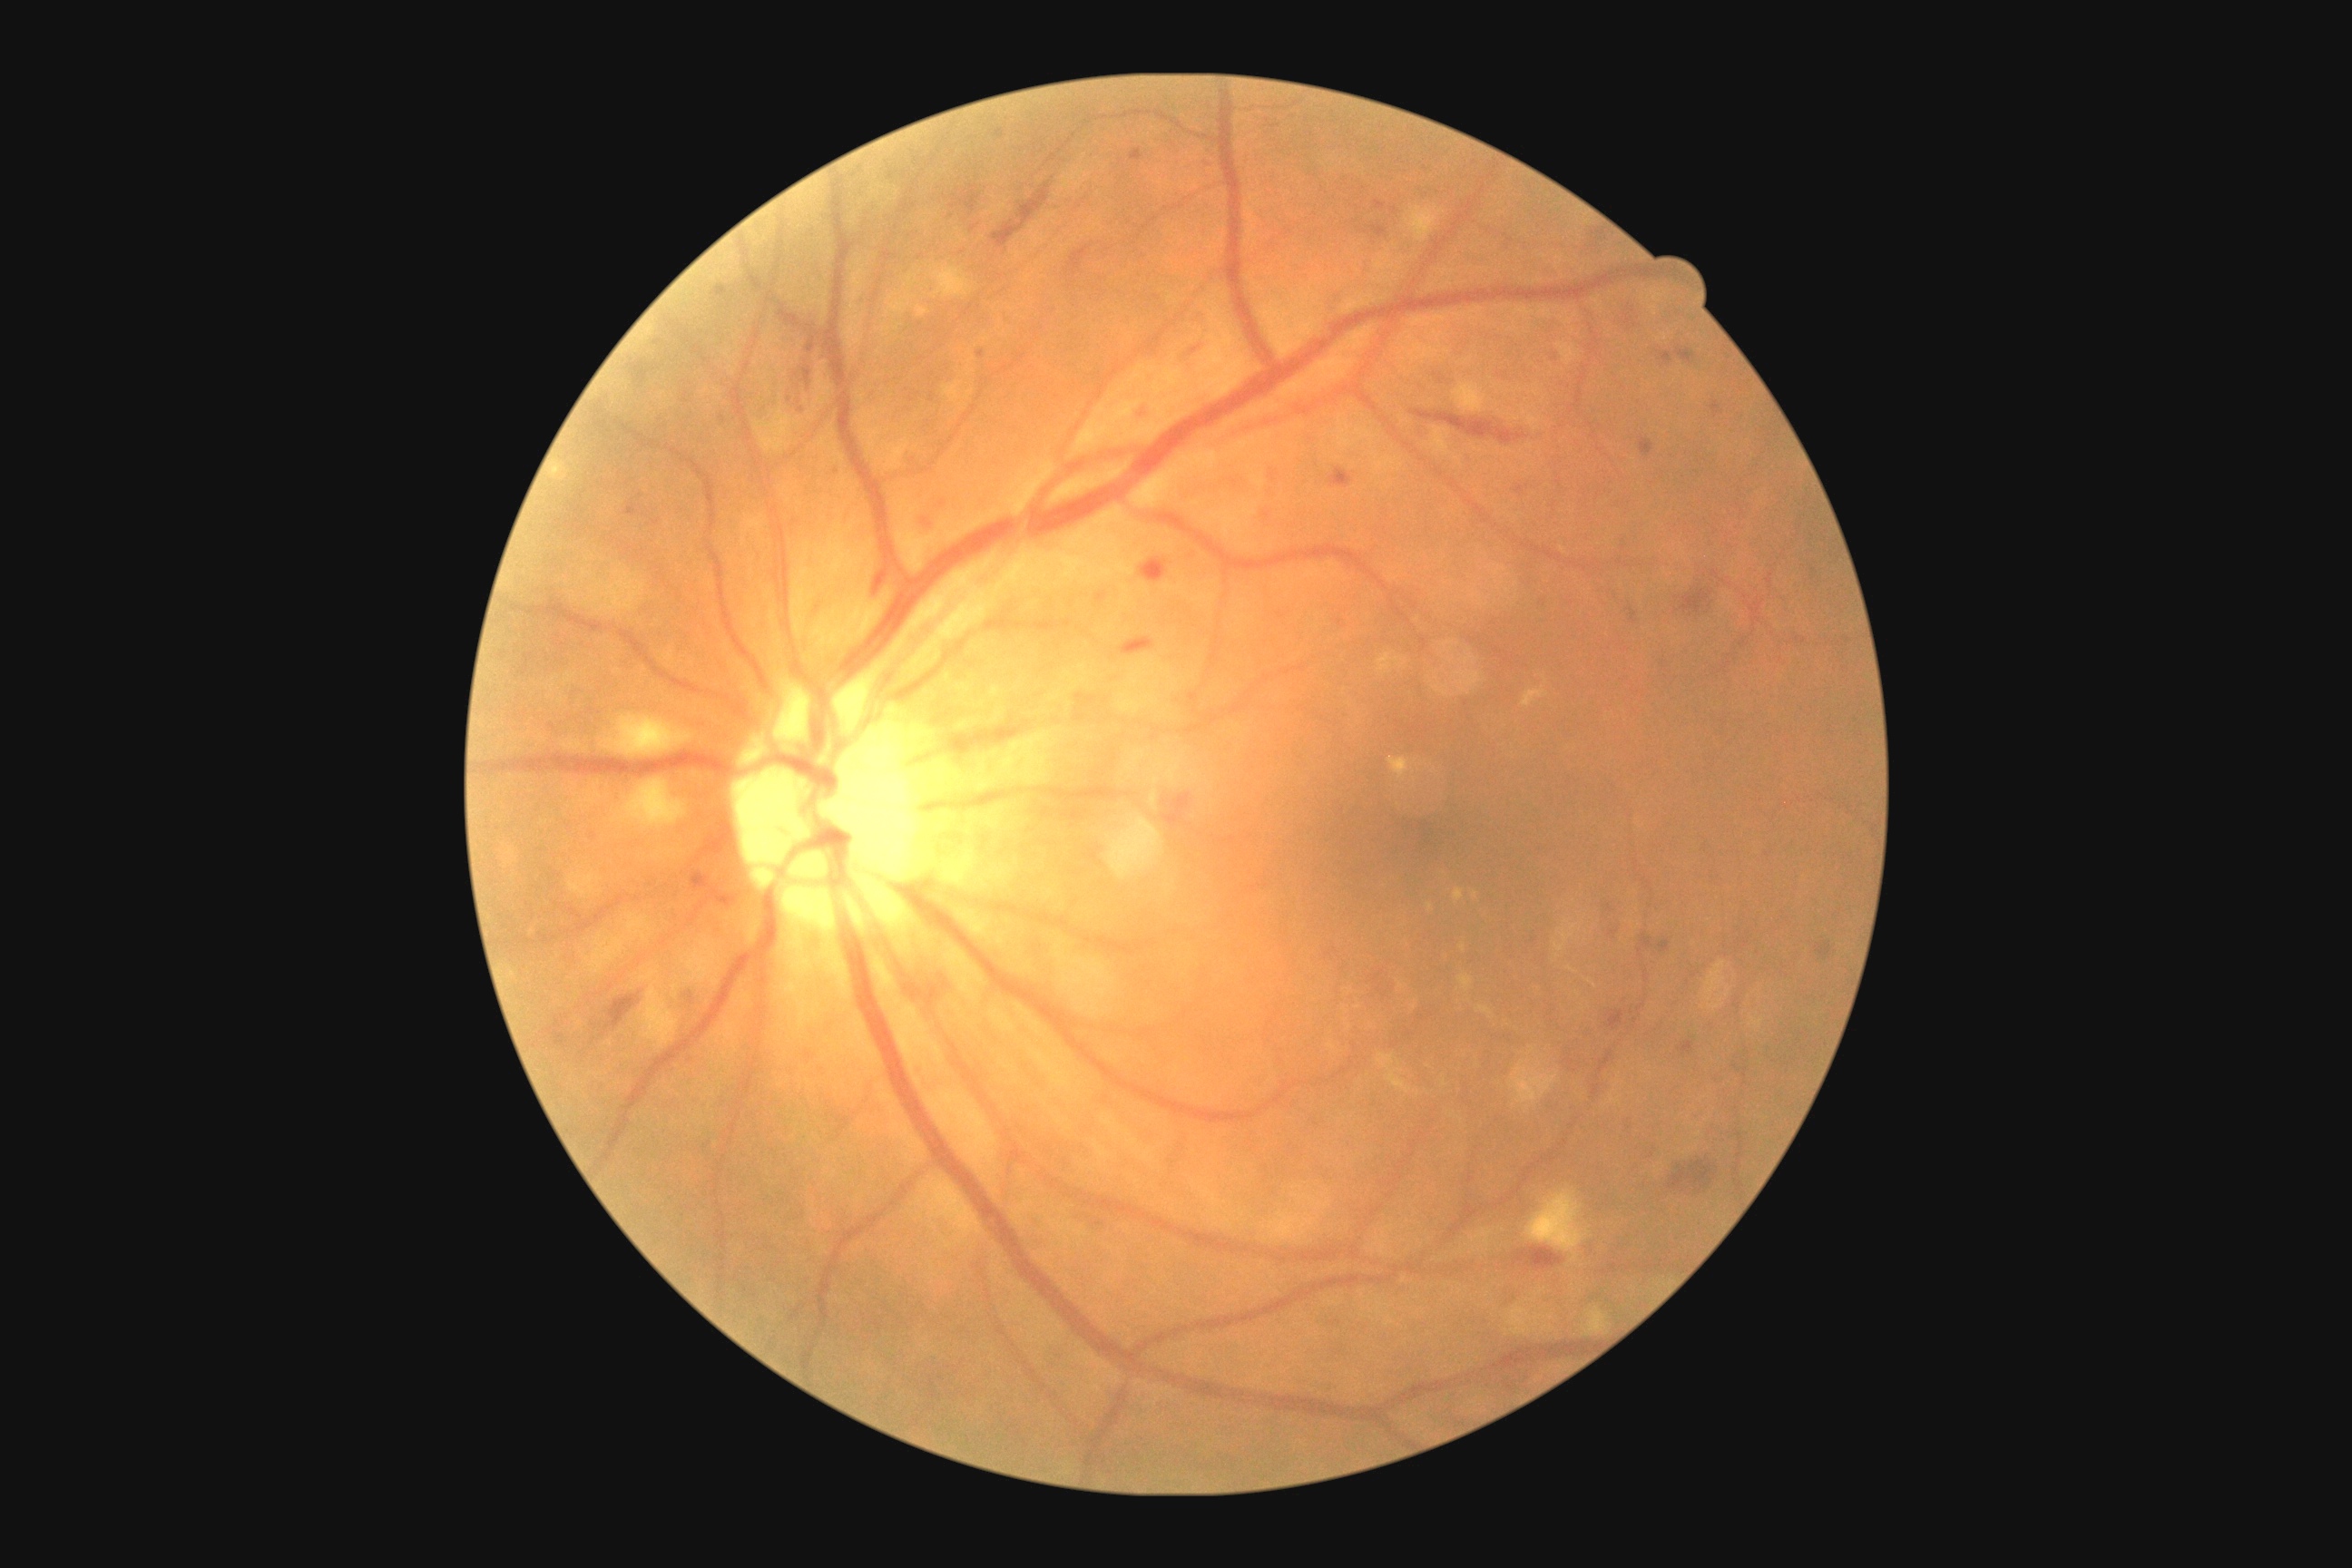 DR class: non-proliferative diabetic retinopathy | diabetic retinopathy: grade 2 (moderate NPDR).